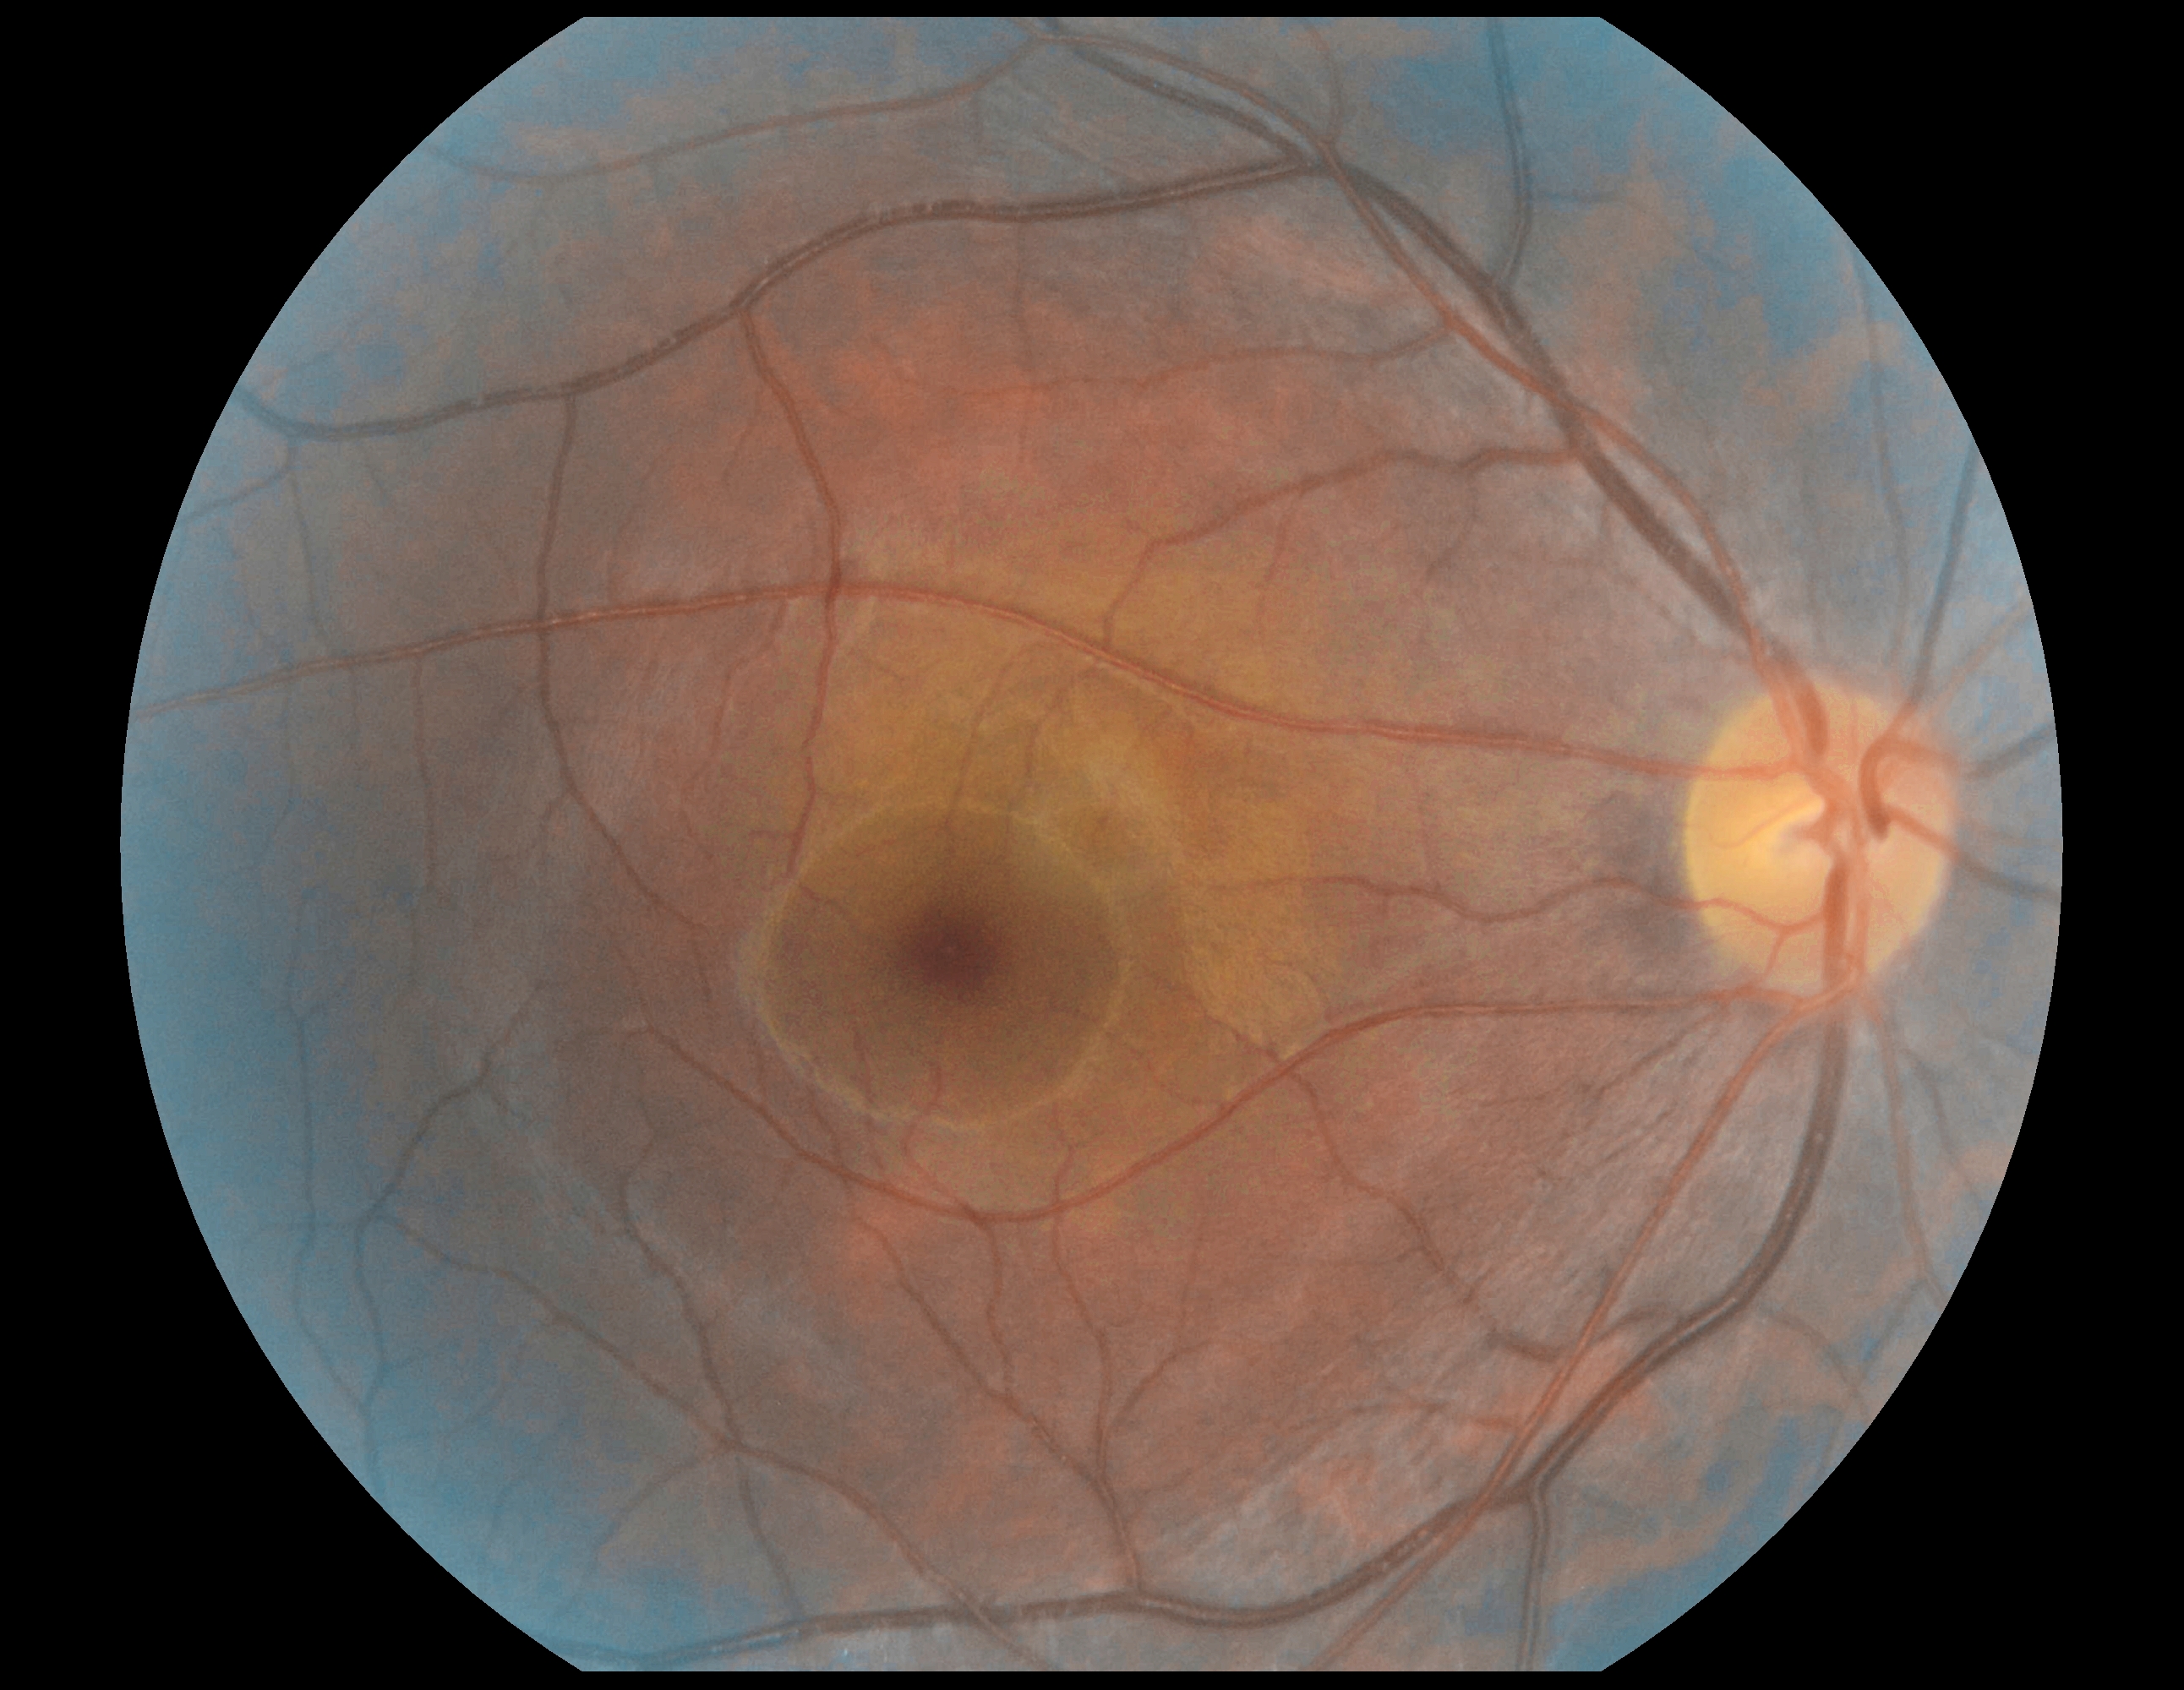
dr_grade: 0 (no apparent retinopathy)